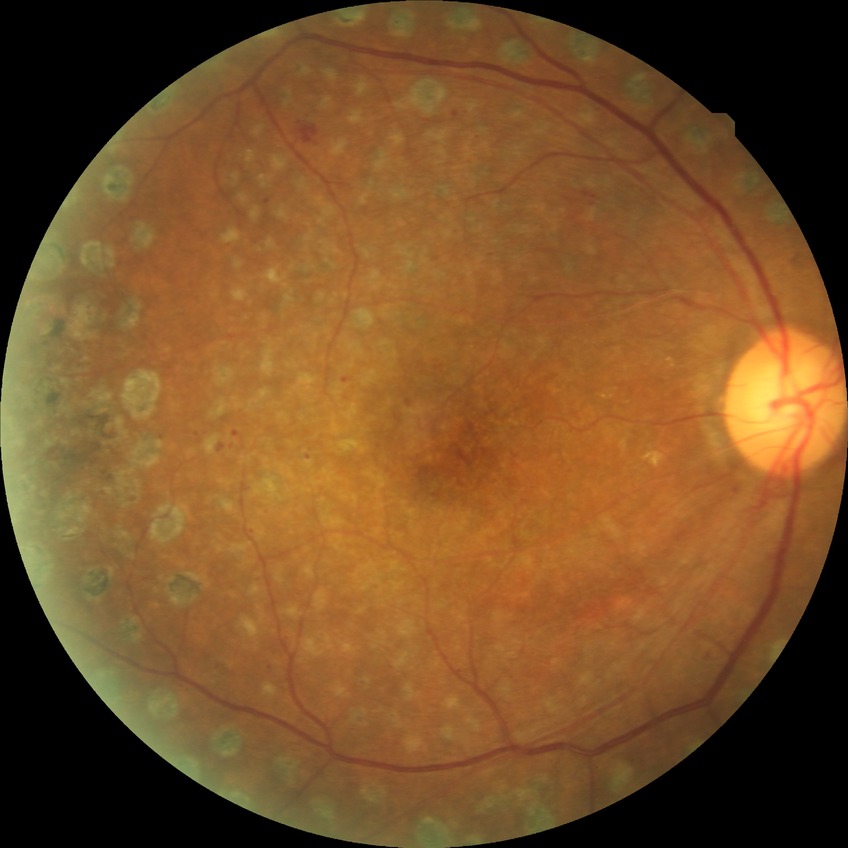
modified Davis classification: proliferative diabetic retinopathy.